Nonmydriatic fundus photograph
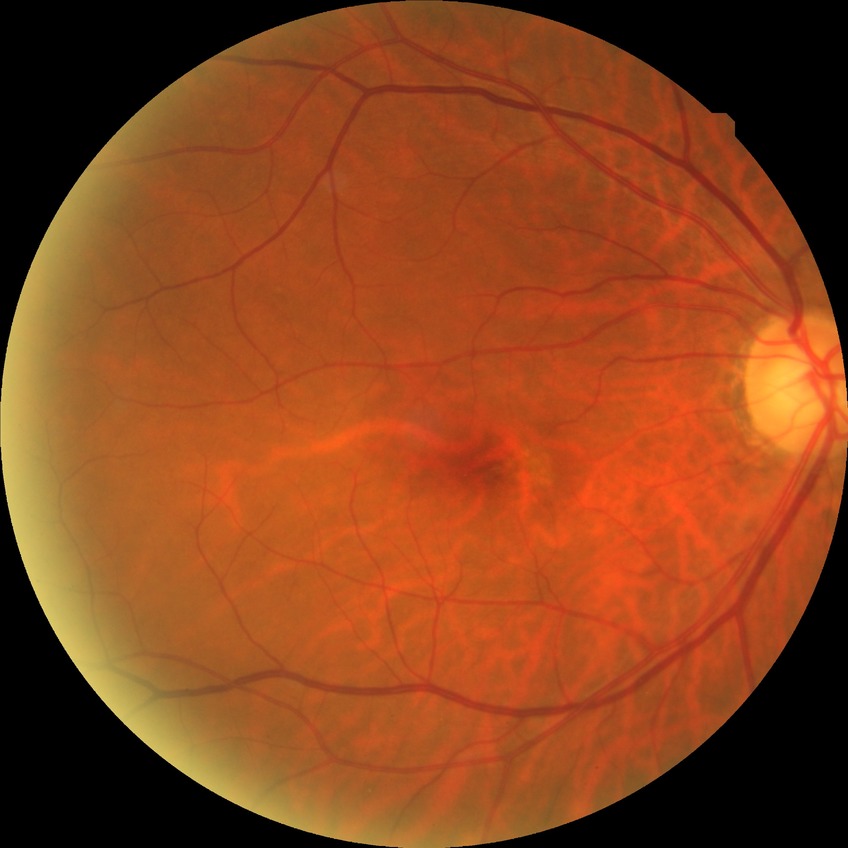
Diabetic retinopathy (DR) is no diabetic retinopathy (NDR).